Acquired with a NIDEK AFC-230. 848x848px
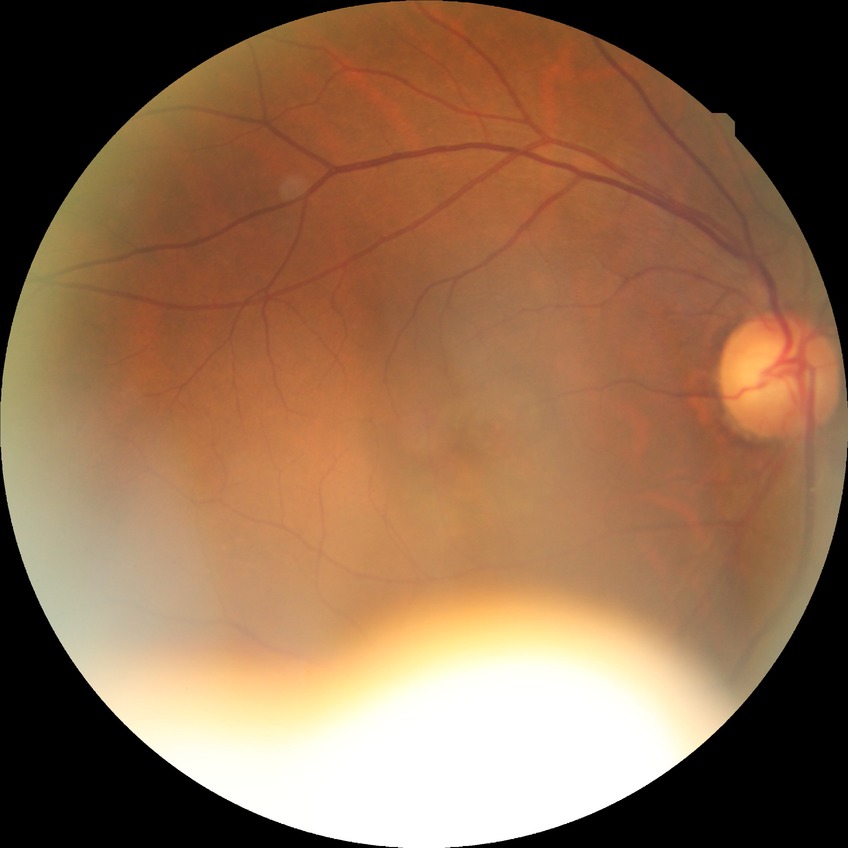

Diabetic retinopathy (DR): NDR (no diabetic retinopathy).